848x848px, 45-degree field of view.
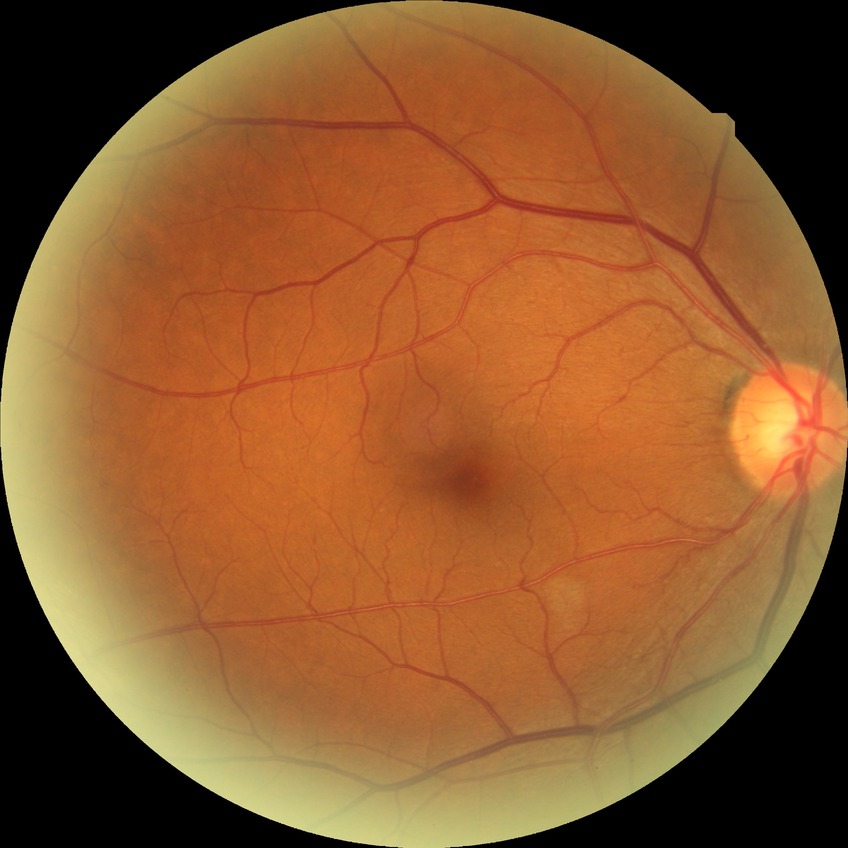 – DR impression — no DR findings
– Davis stage — NDR